Color fundus image.
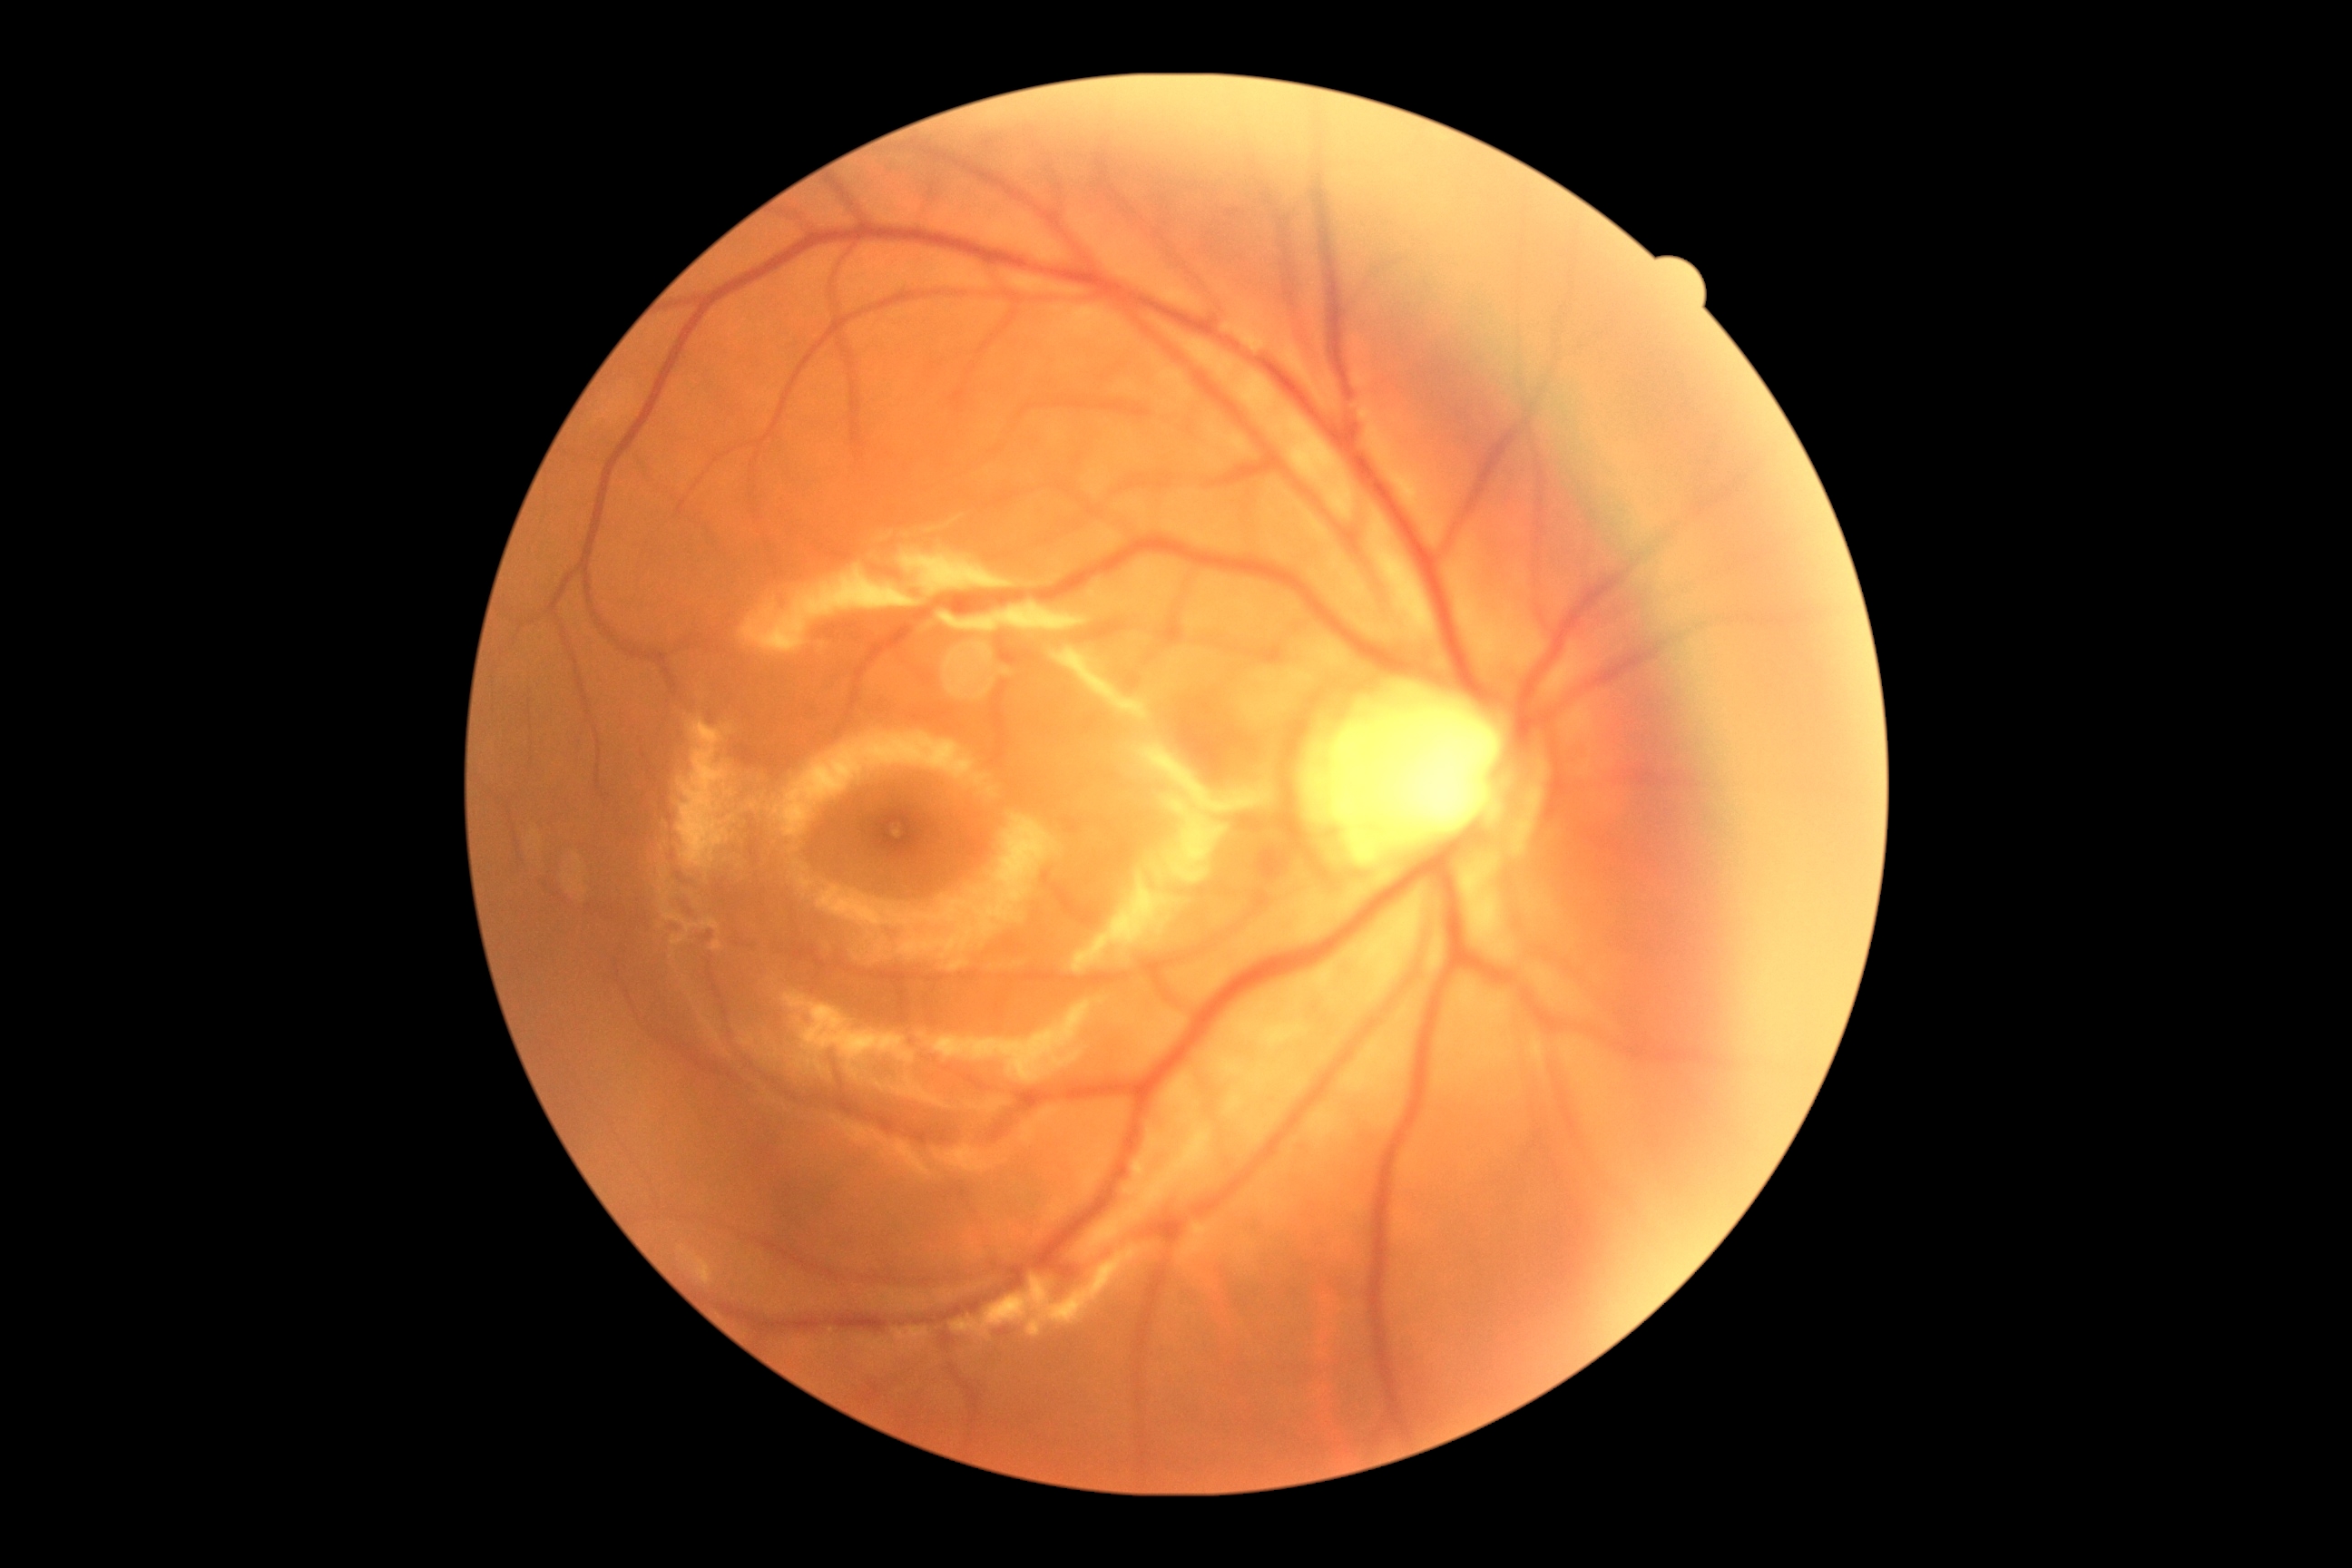
Retinopathy grade is no apparent diabetic retinopathy (0).